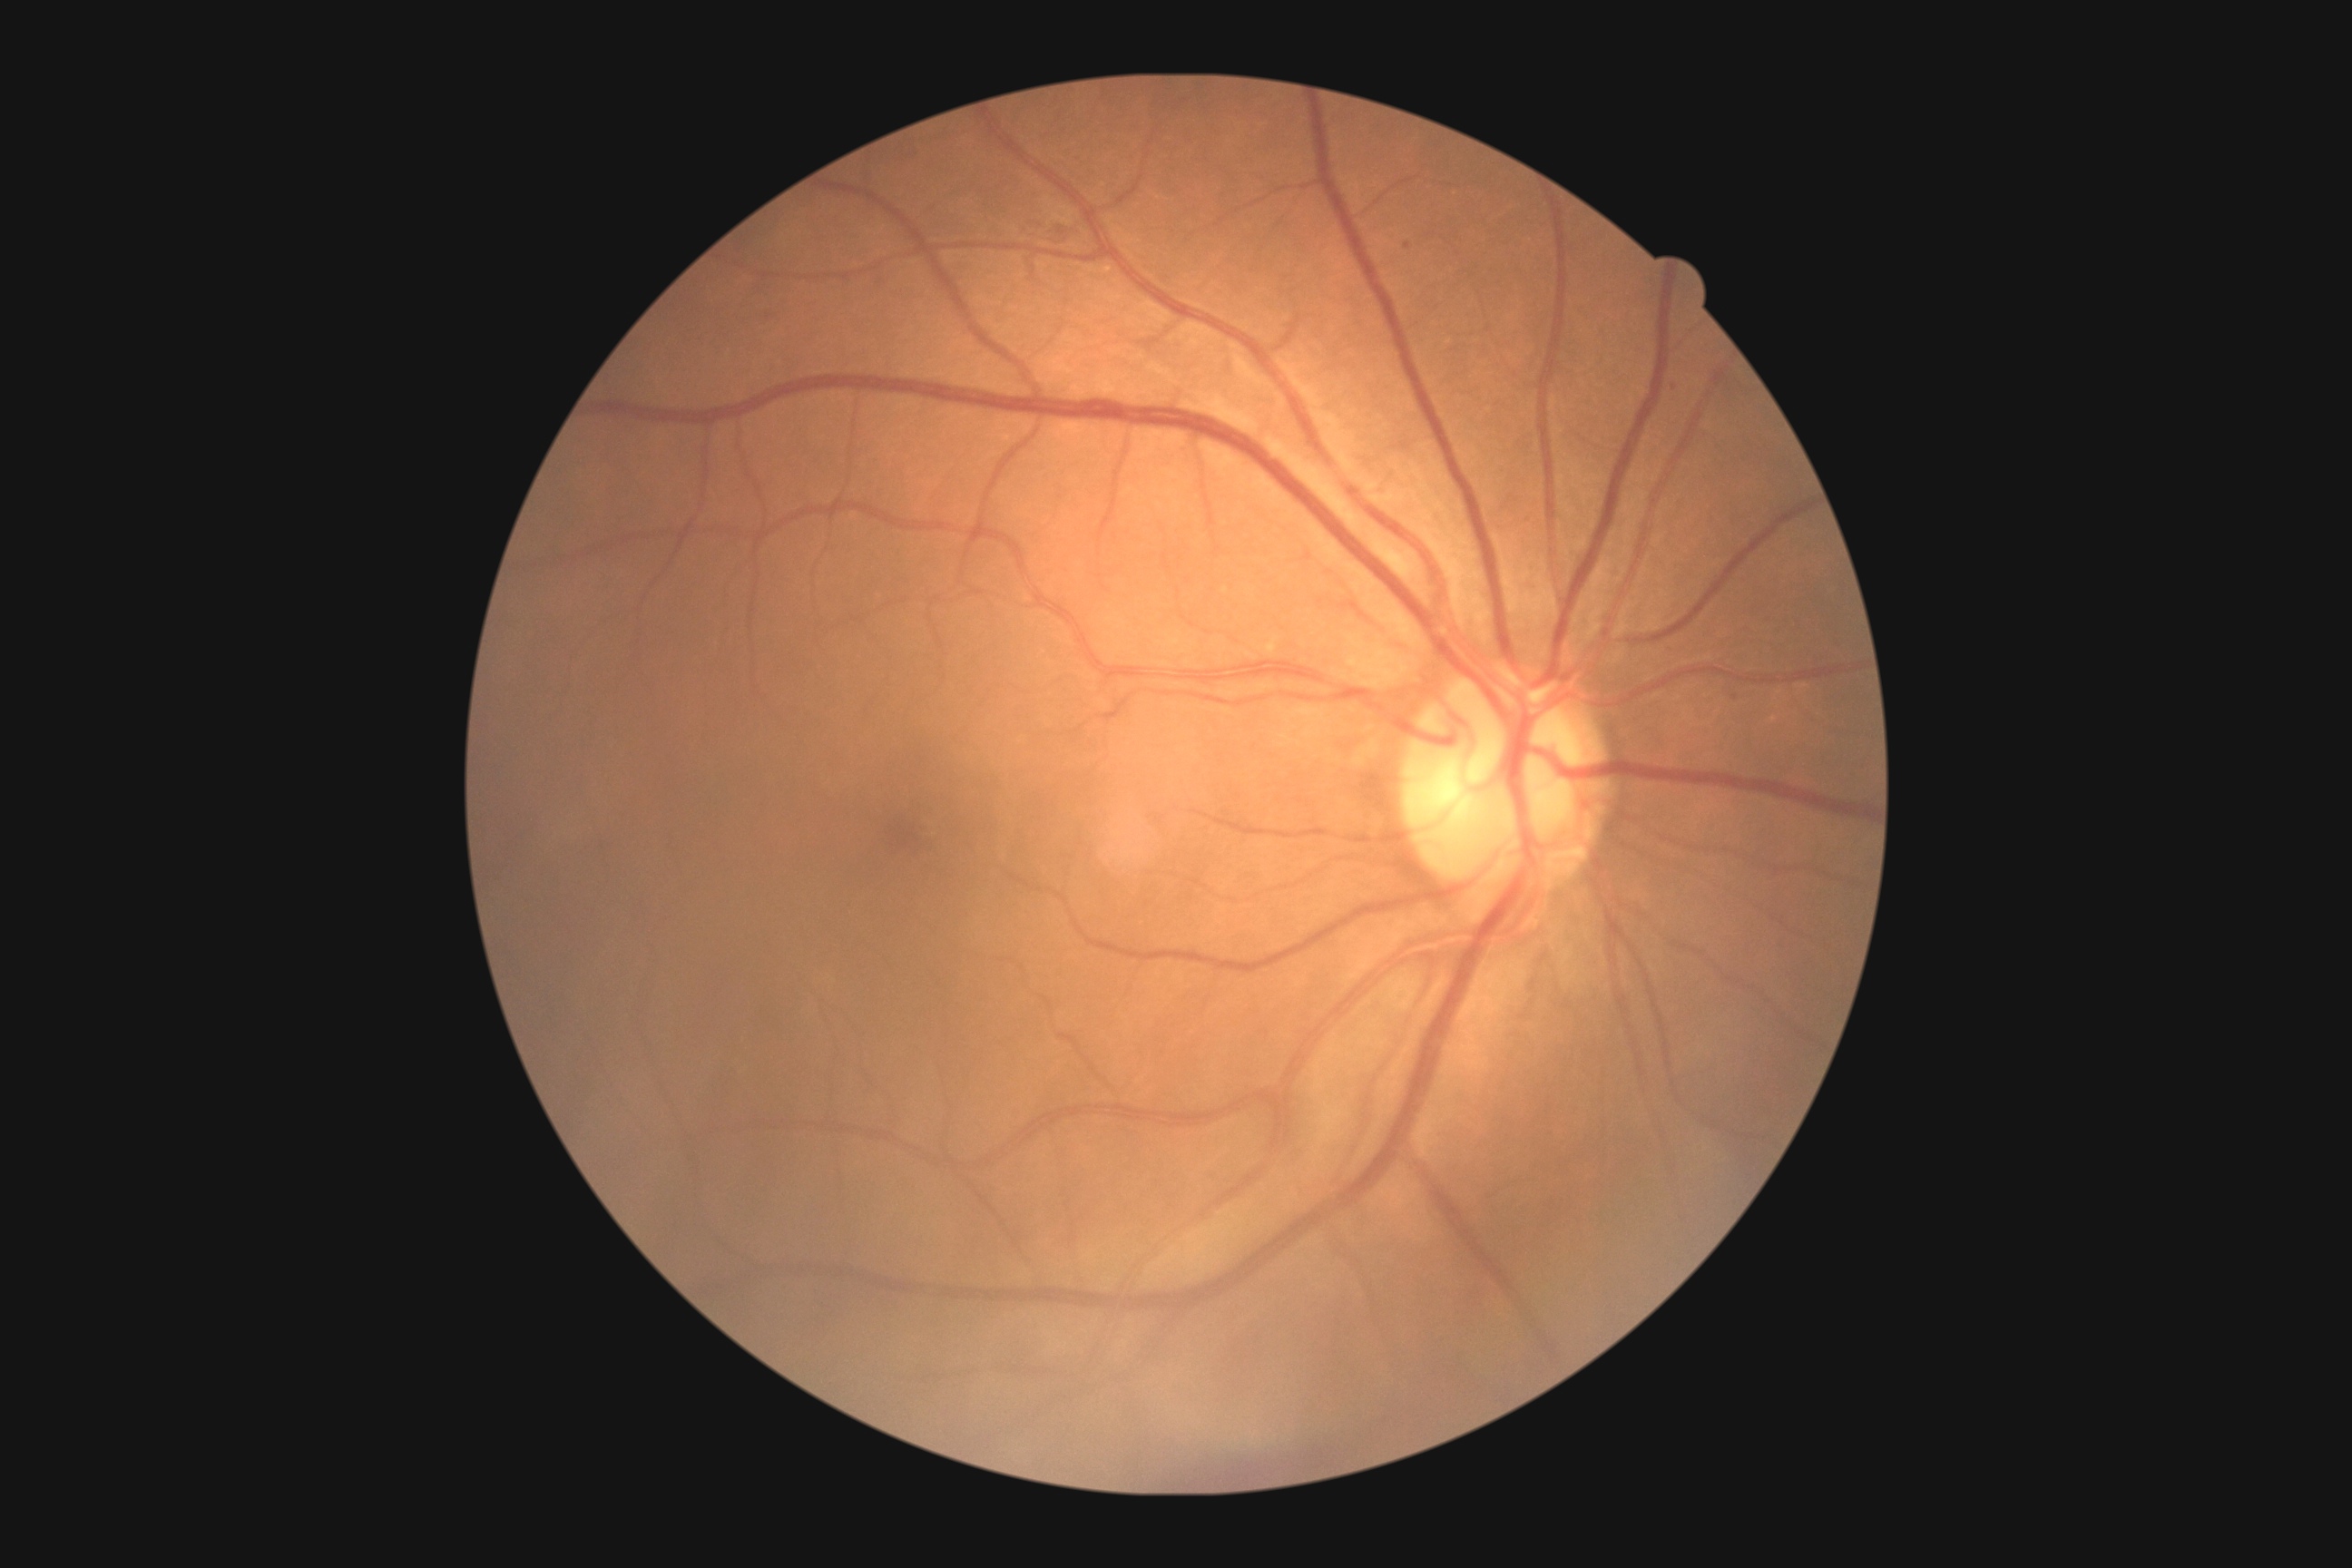

DR: grade 2 (moderate NPDR).